Infant wide-field fundus photograph.
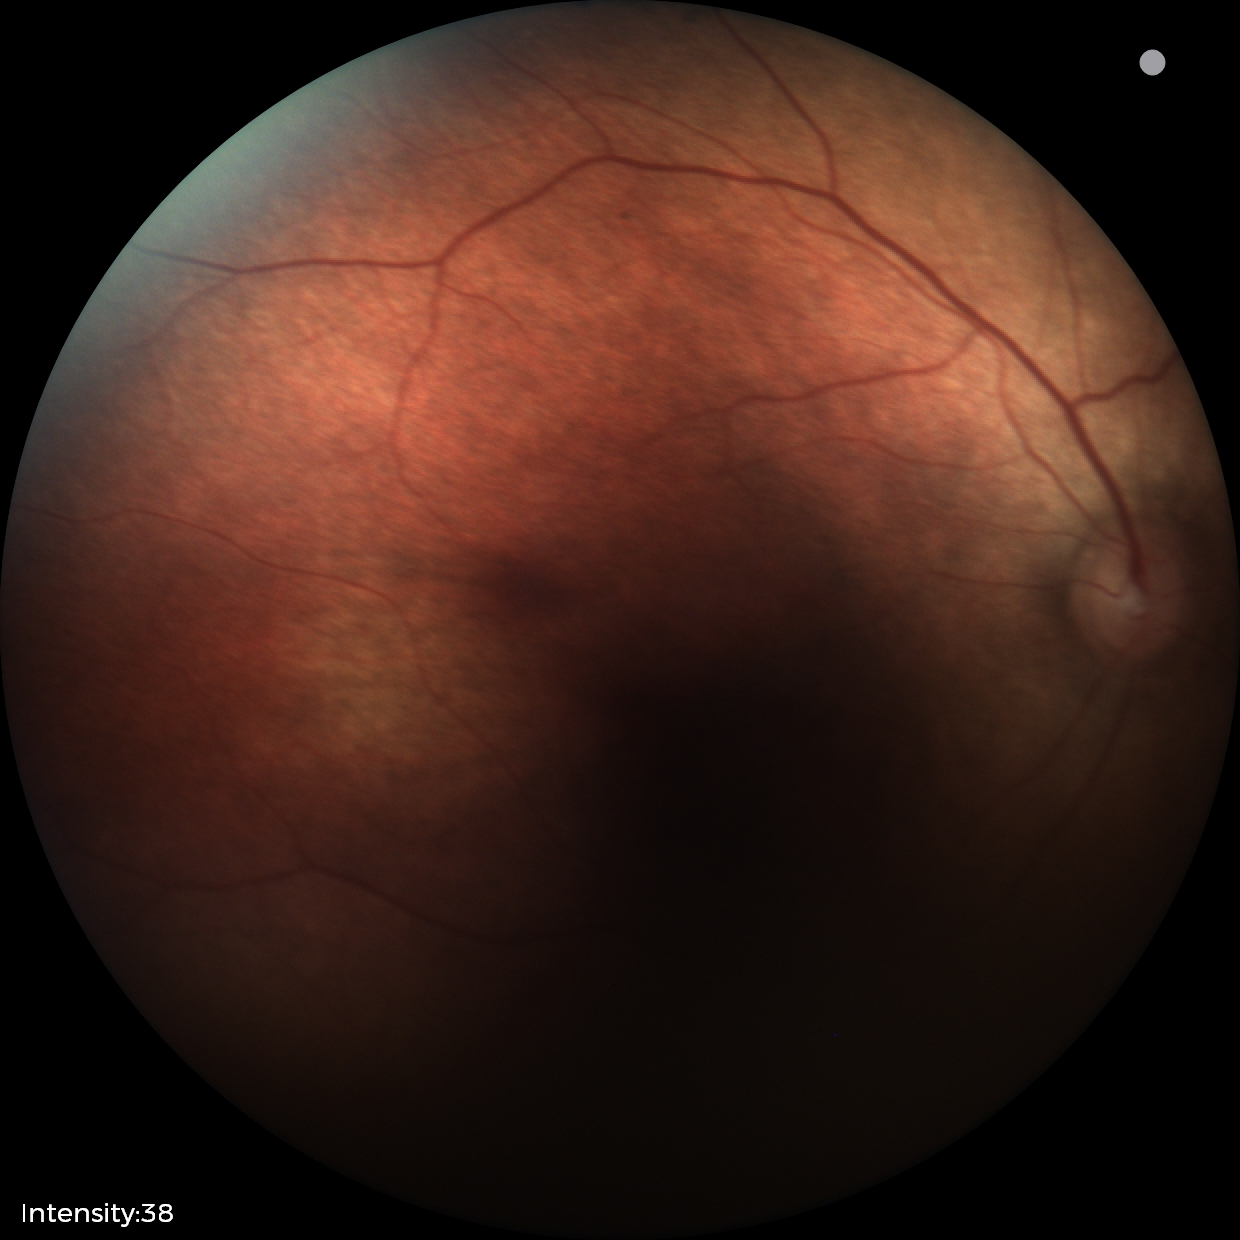
Impression: normal.